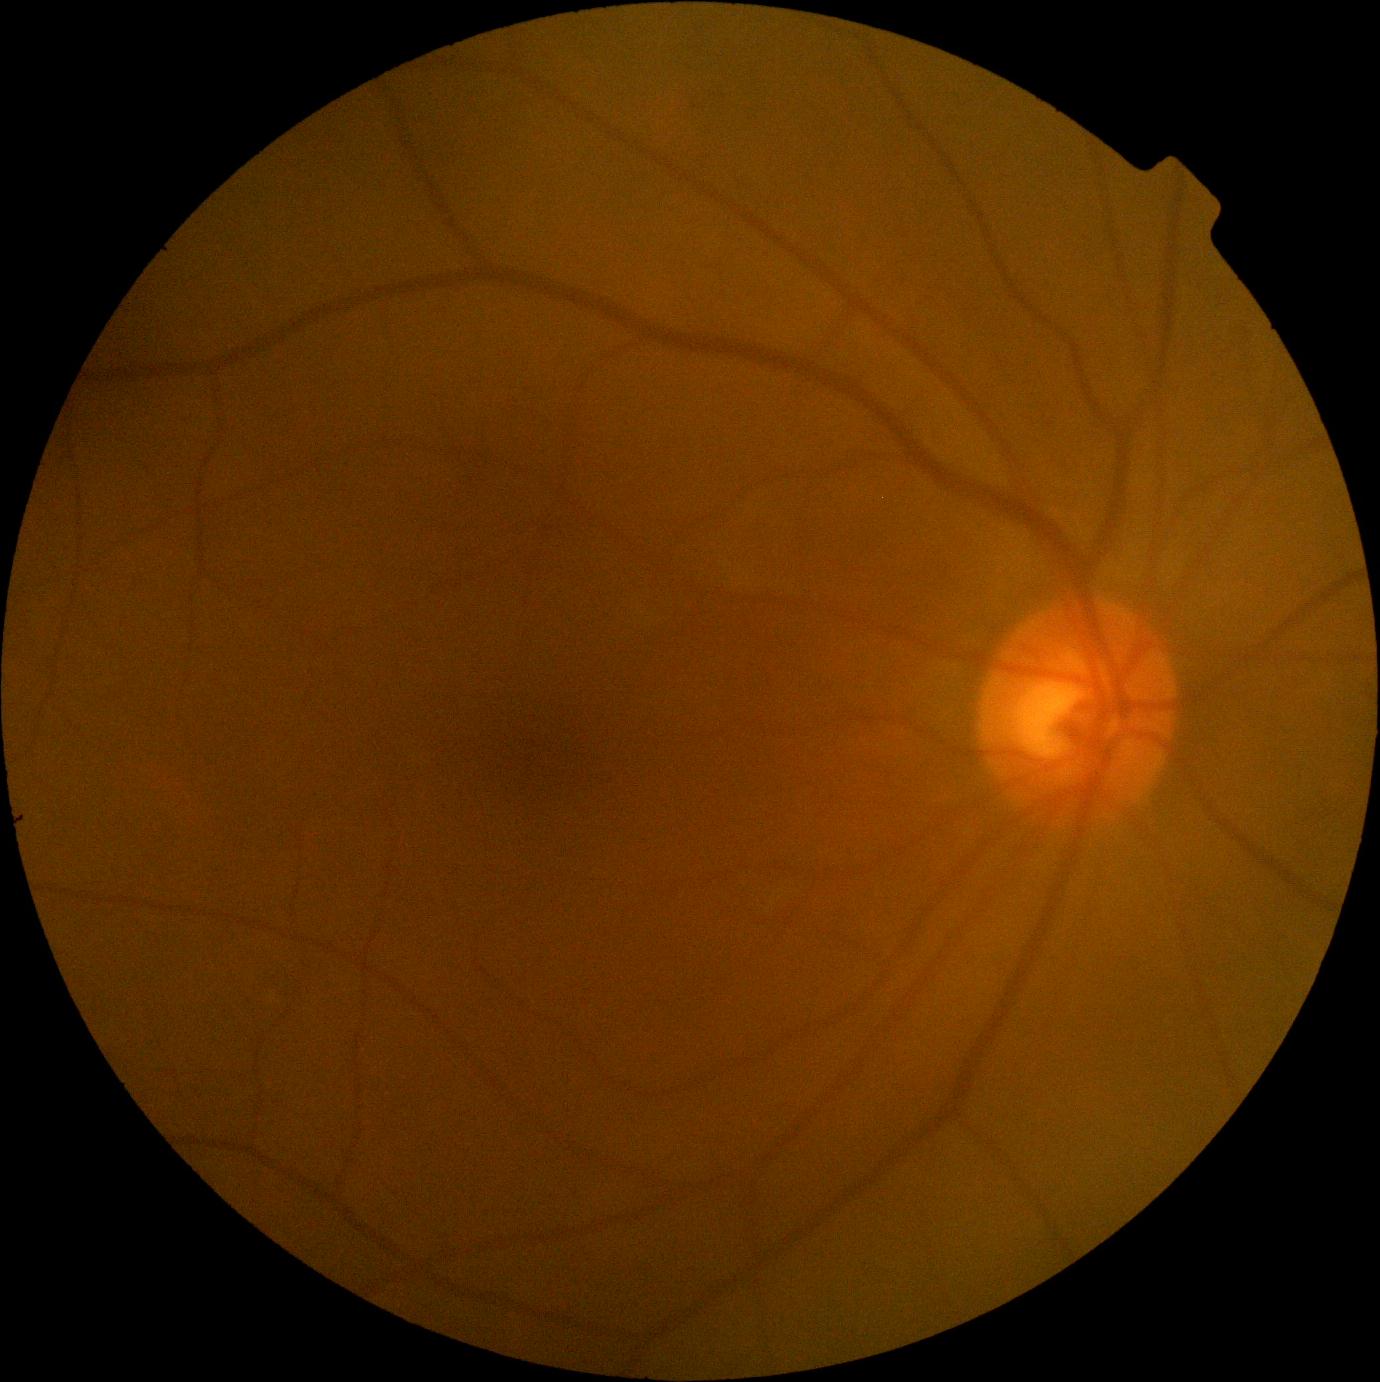

Diabetic retinopathy (DR) is 0/4.
No diabetic retinal disease findings.